Acquired with a NIDEK AFC-230; without pupil dilation; graded on the modified Davis scale — 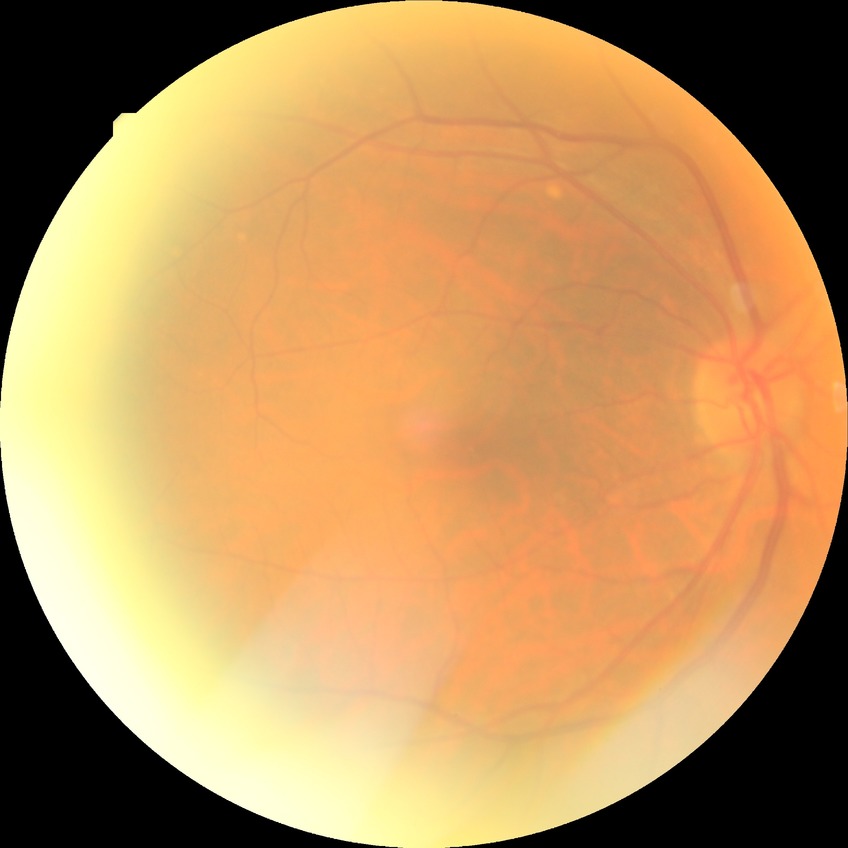 Davis grade: SDR.